2352x1568px, CFP, FOV: 45 degrees: 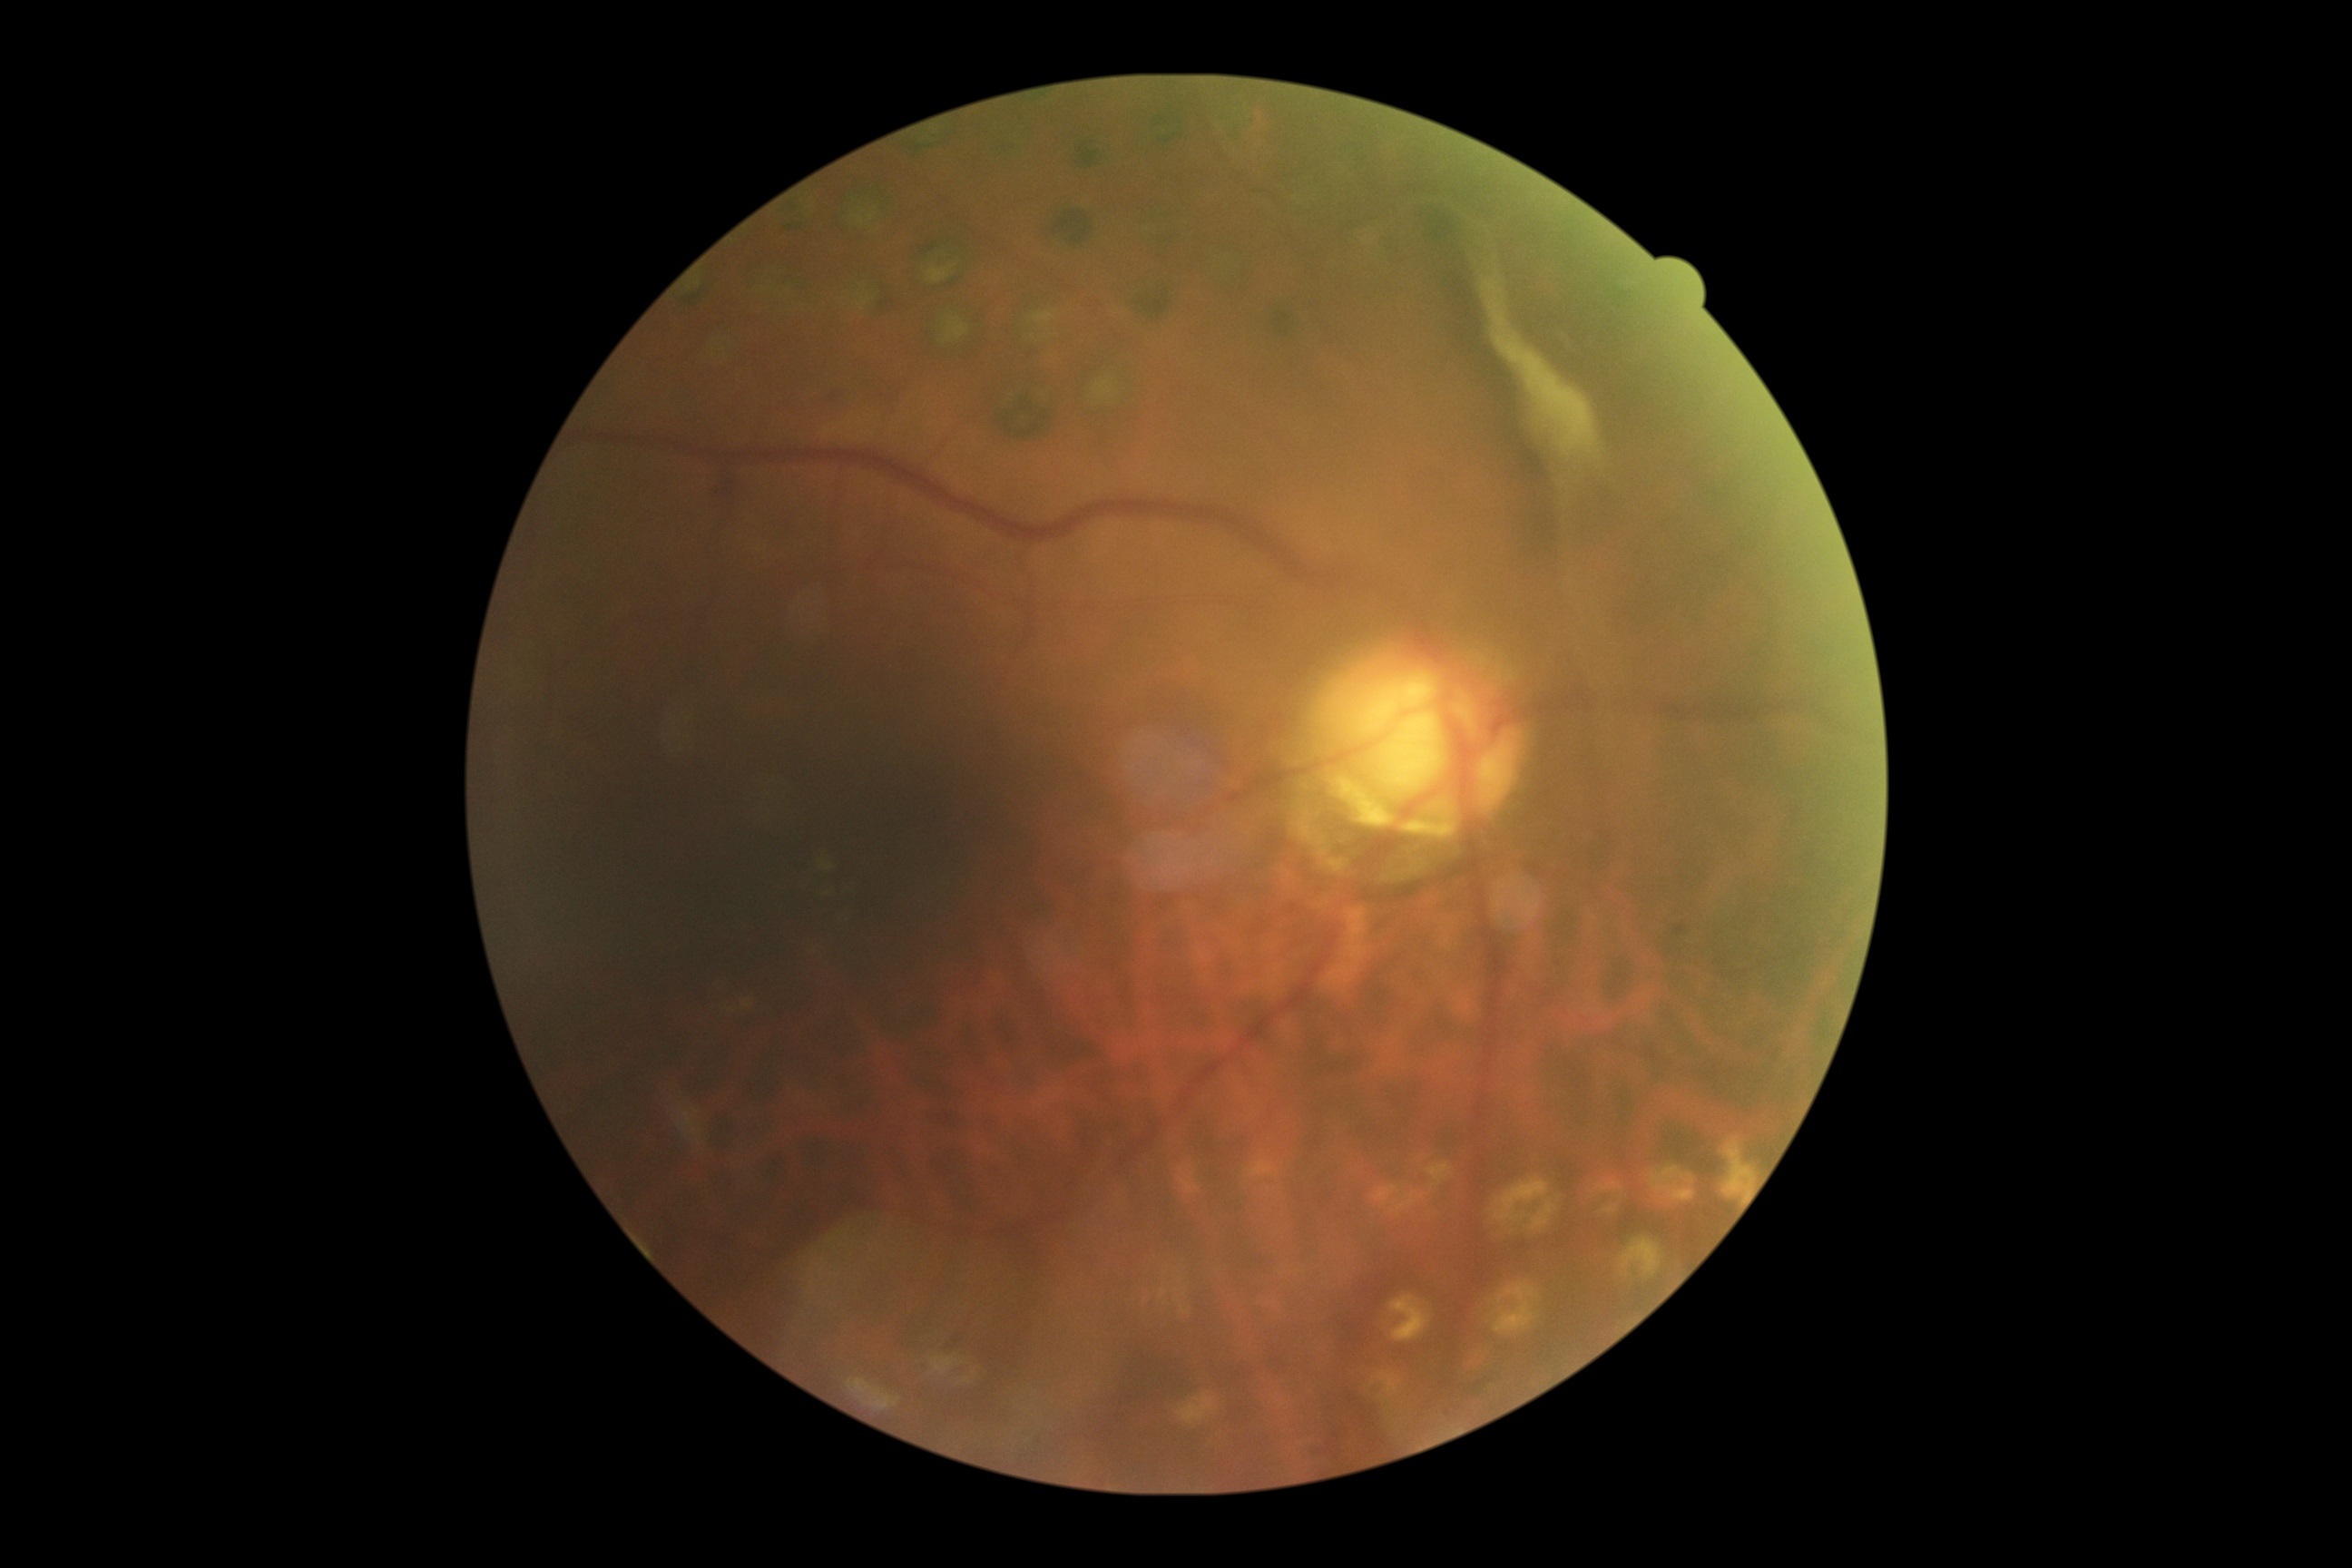 DR@proliferative diabetic retinopathy (grade 4).